Retinal fundus photograph — 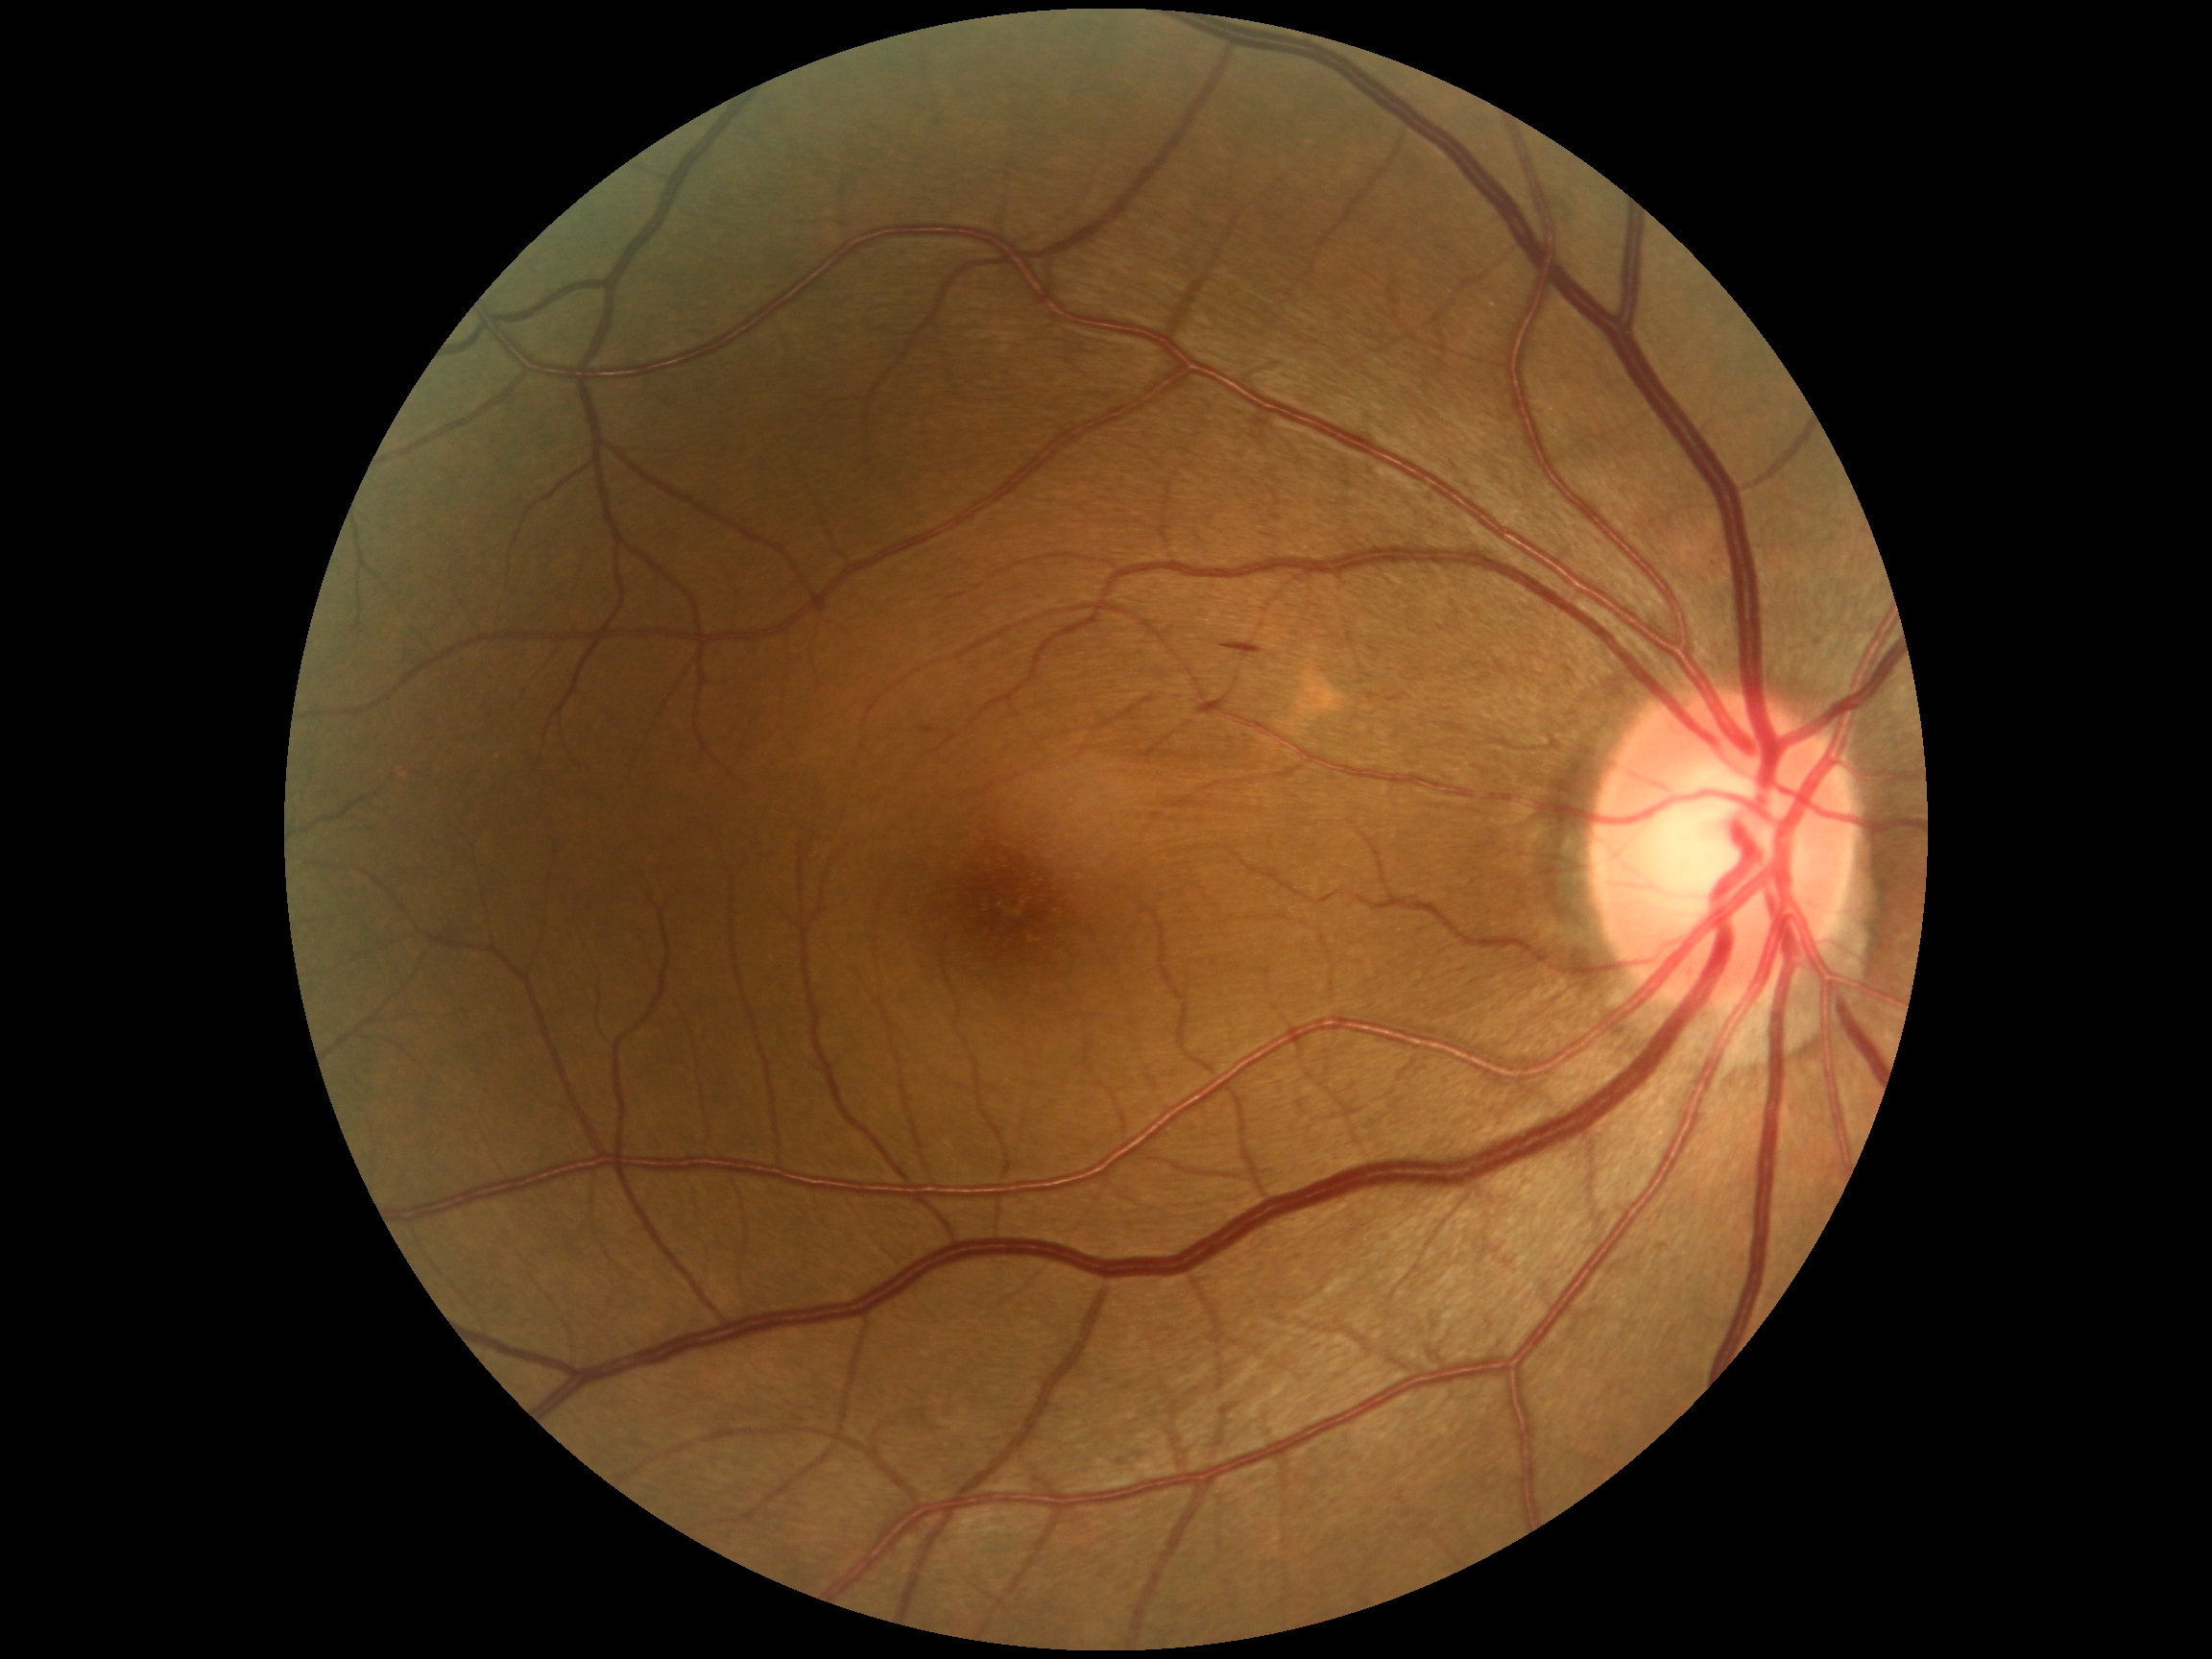

Retinopathy is grade 2. No hard exudates identified. No soft exudates identified. Hemorrhages present at bbox(1221, 643, 1264, 660), bbox(921, 727, 941, 736). No microaneurysms identified.